Centered on the macula
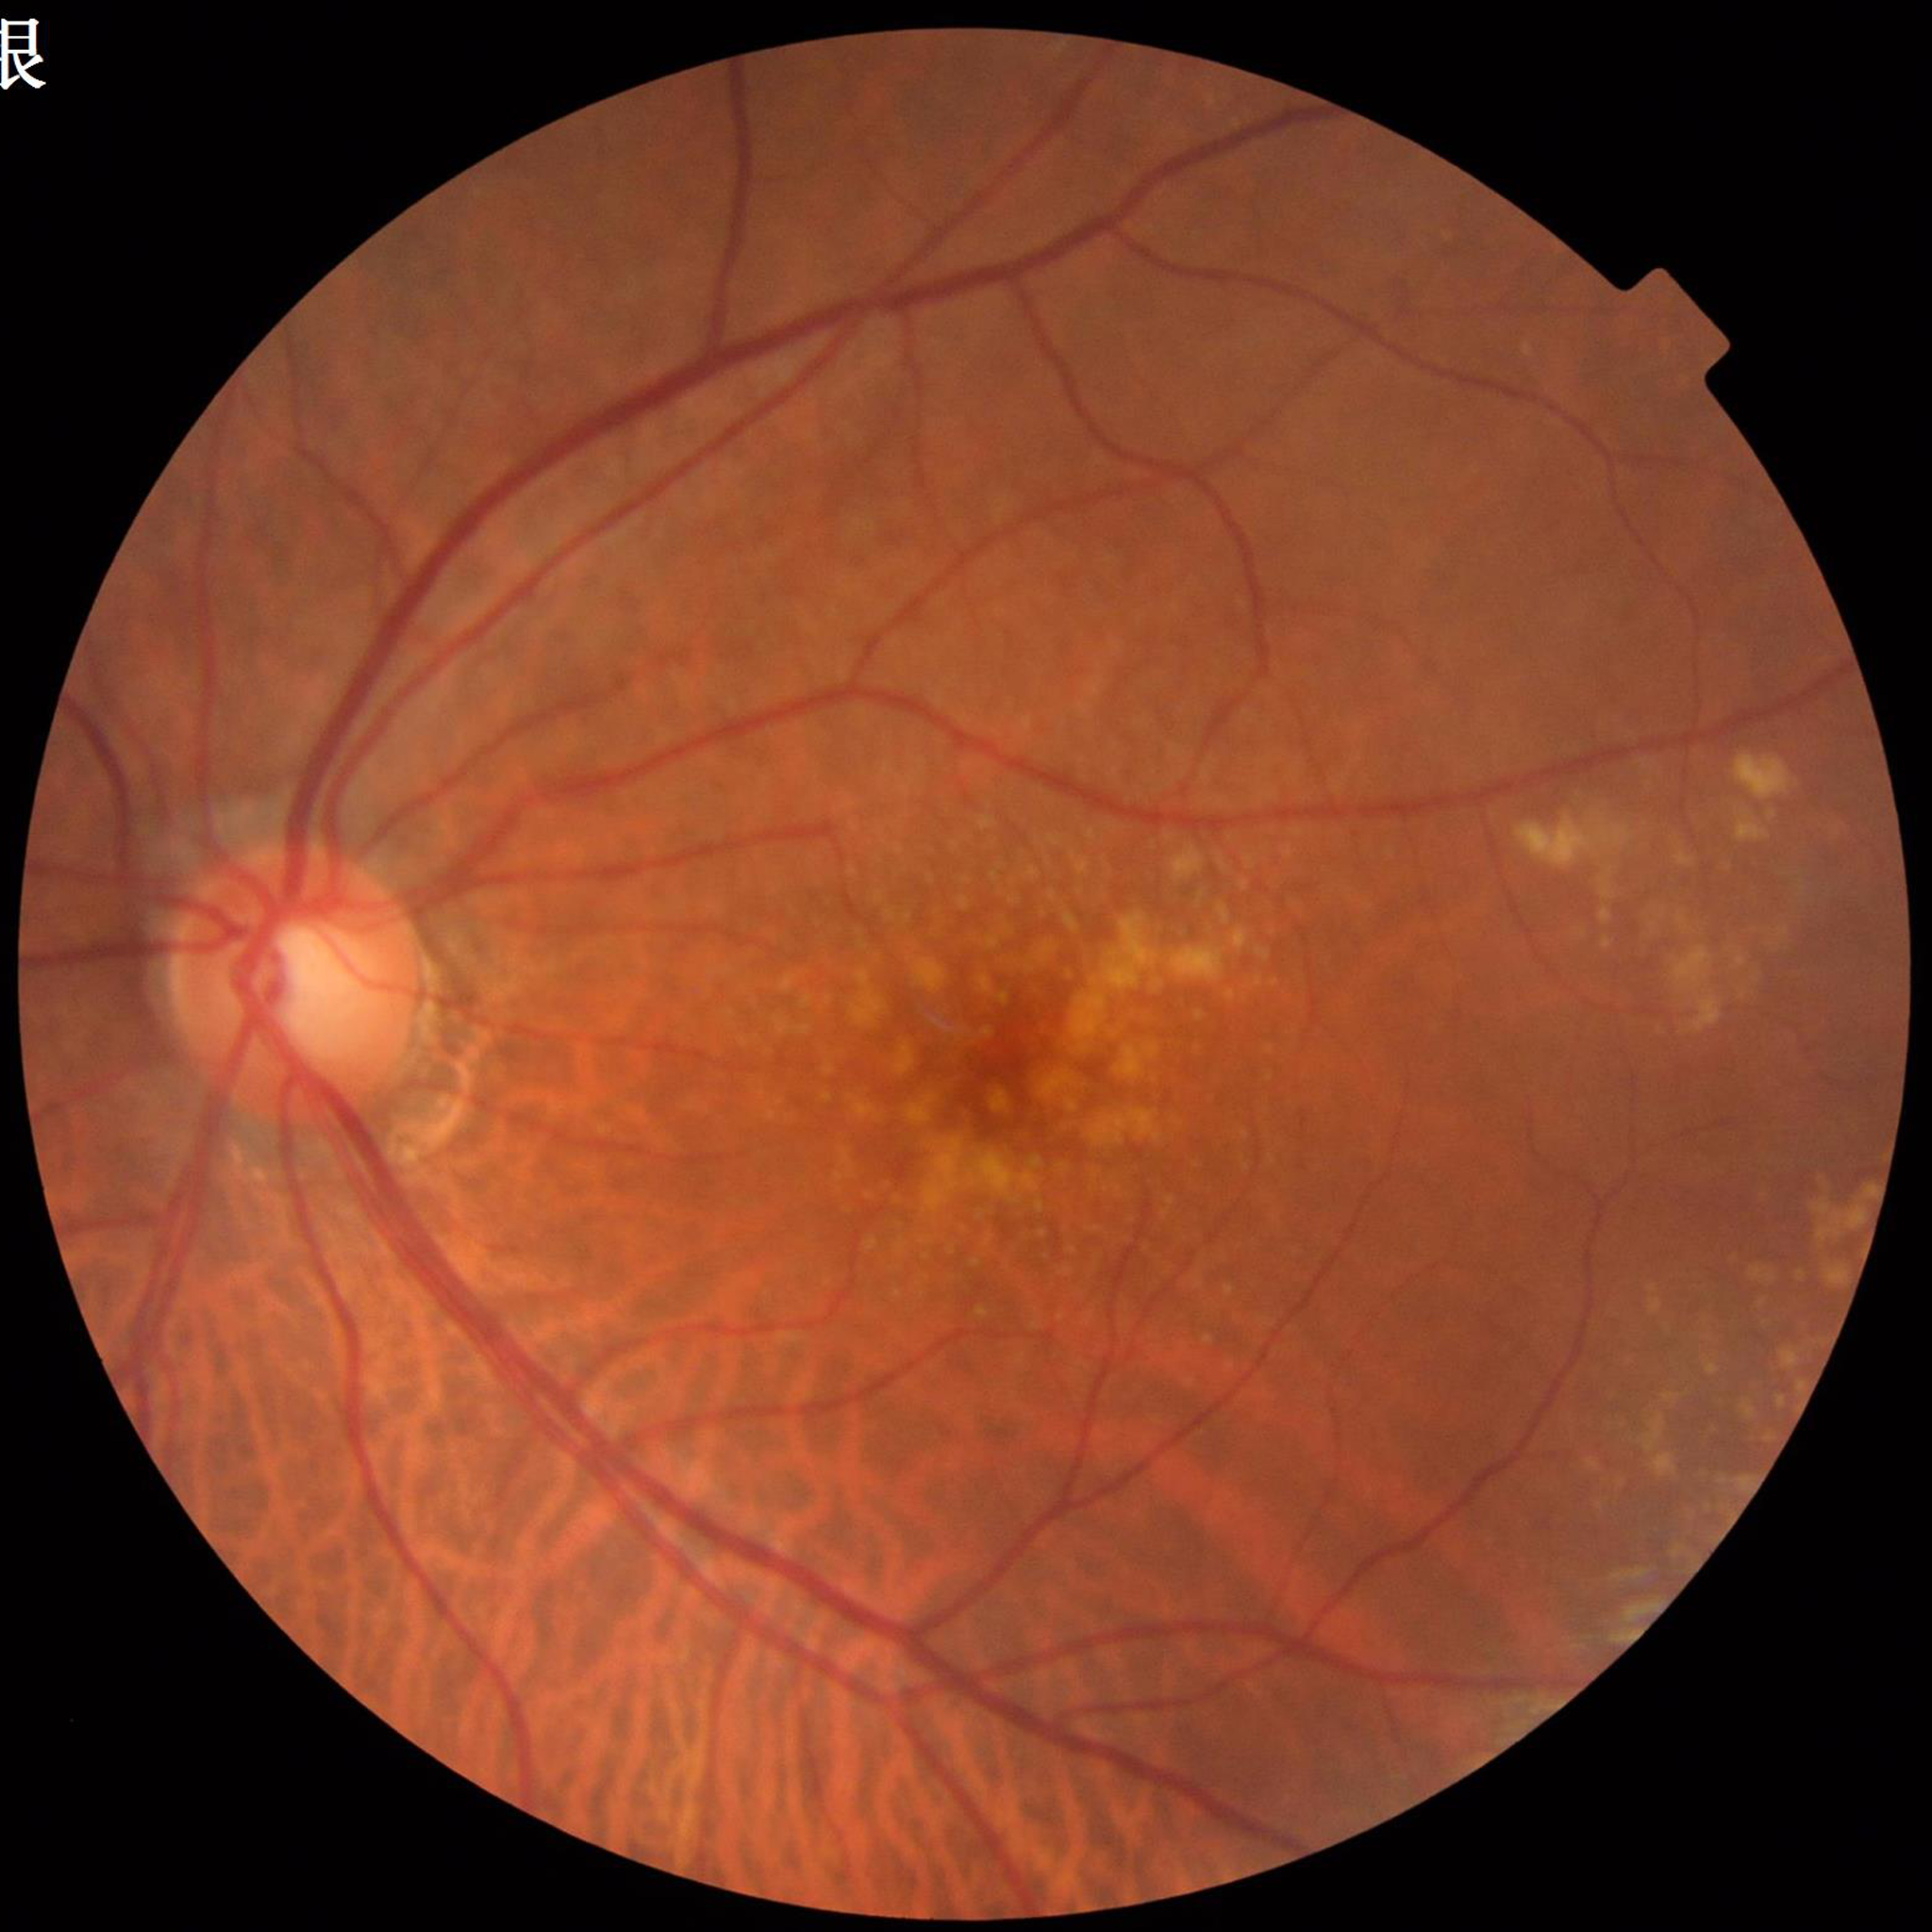 The patient was diagnosed with age-related macular degeneration.